45° field of view: 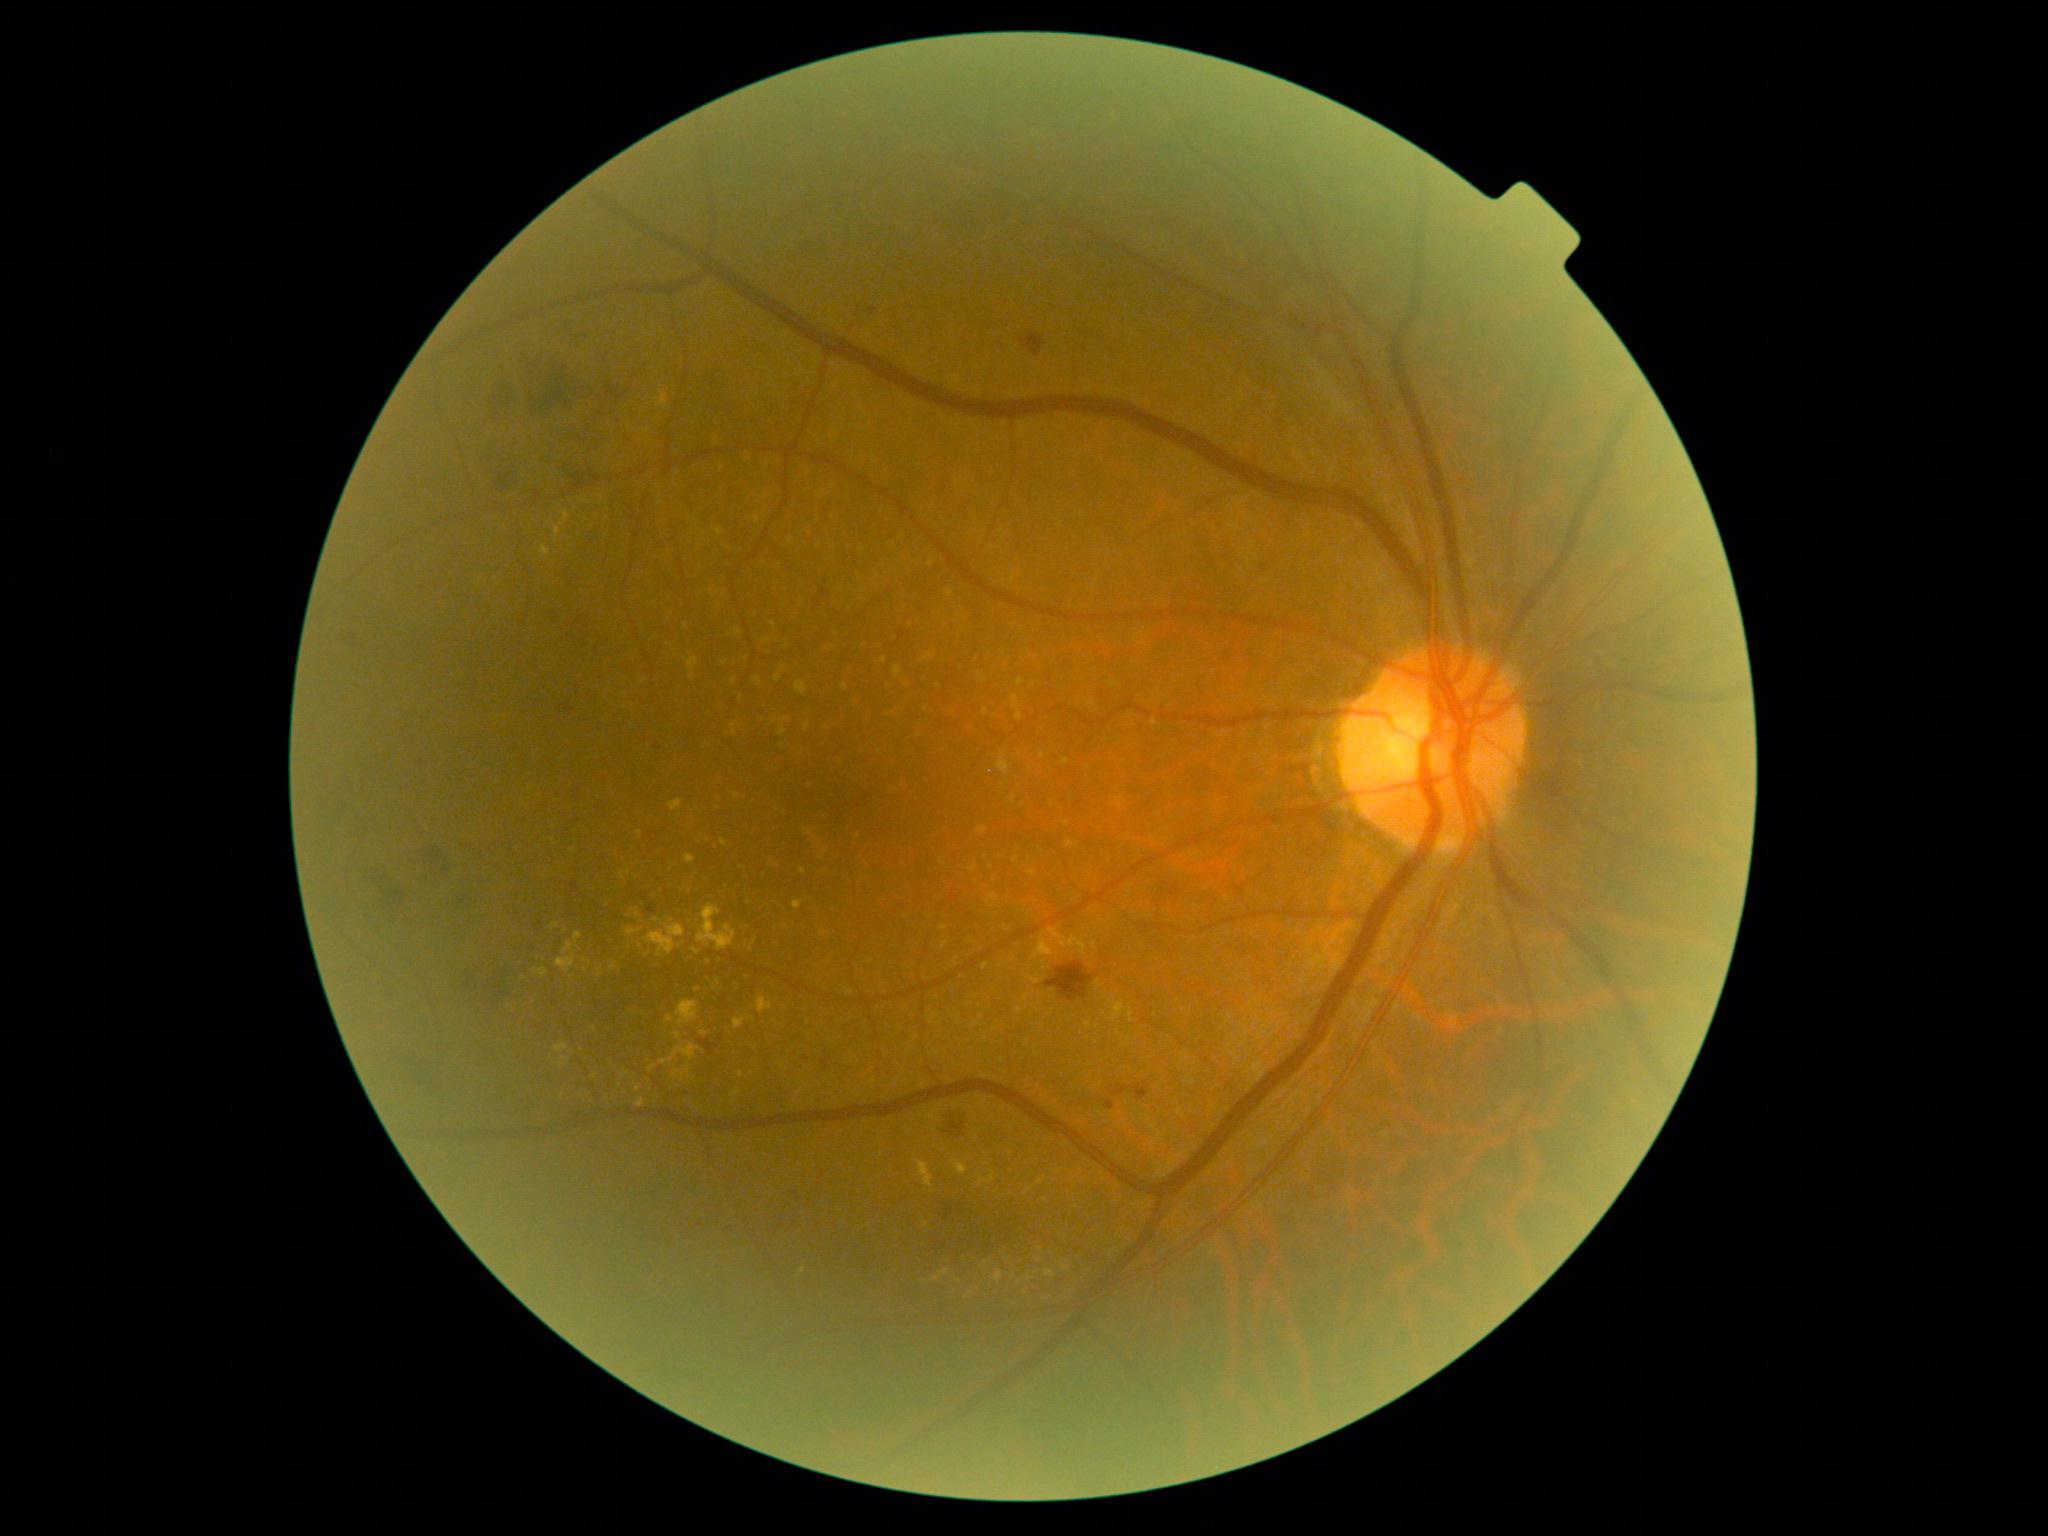
partial: true
dr_grade: 2
dr_grade_name: moderate NPDR
lesions:
  ex:
    - bbox=[556, 931, 582, 973]
    - bbox=[1037, 1177, 1047, 1185]
    - bbox=[700, 1030, 708, 1036]
    - bbox=[721, 839, 729, 846]
    - bbox=[632, 908, 641, 918]
    - bbox=[555, 1045, 569, 1053]
    - bbox=[536, 968, 548, 979]
    - bbox=[980, 1172, 996, 1184]
    - bbox=[759, 996, 773, 1014]
    - bbox=[750, 940, 756, 950]
  ex_small:
    - (719; 983)
    - (1011; 1155)
    - (927; 1224)
    - (1038; 1272)
    - (596; 1076)
    - (670; 1019)
    - (1040; 1249)
    - (741; 1075)